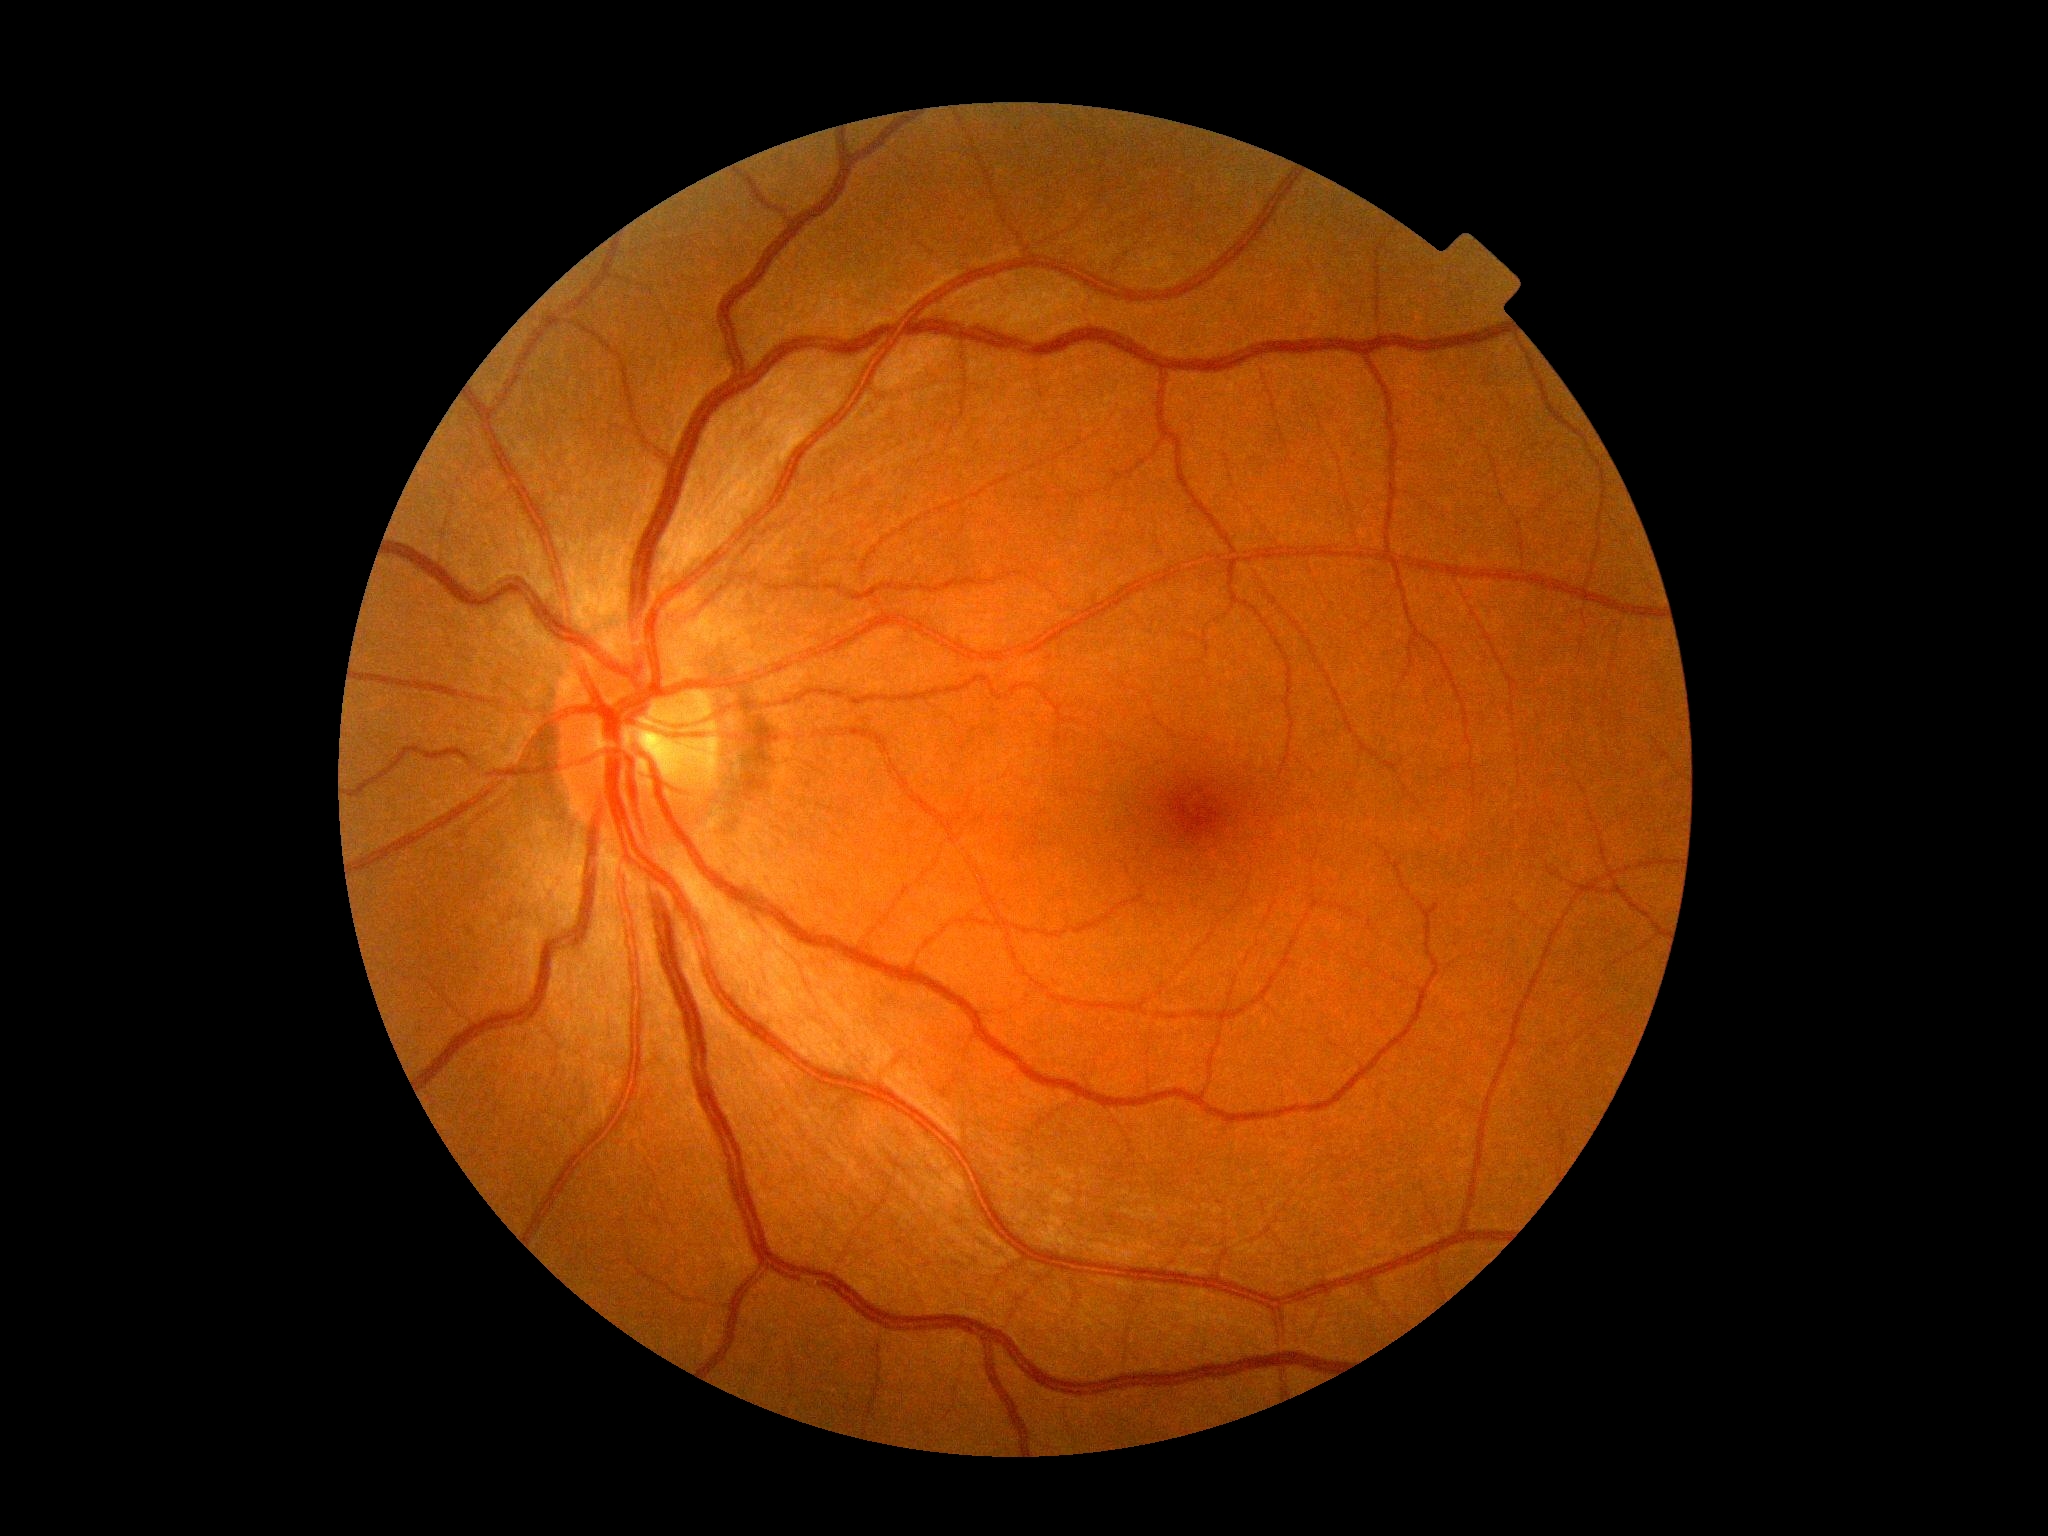 diabetic retinopathy grade: 0; DR impression: negative for DR.